Acquired on the Natus RetCam Envision; infant wide-field retinal image: 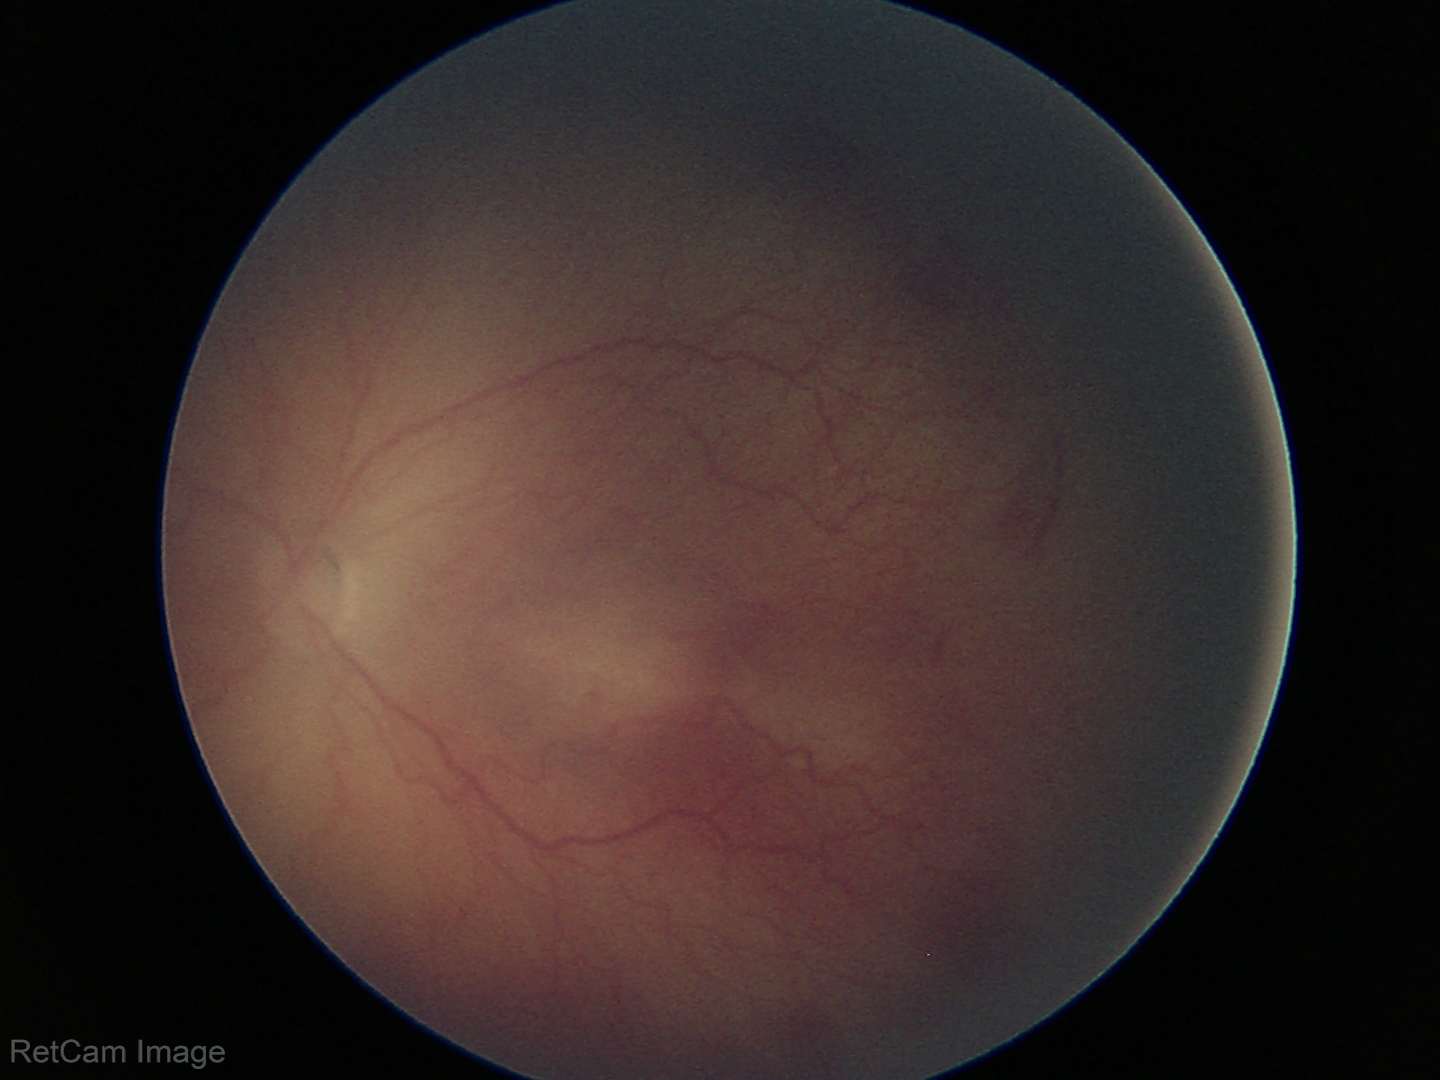

Plus disease = absent; assessment = retinopathy of prematurity stage 2.